Image size 2352x1568; retinal fundus photograph; 45° field of view.
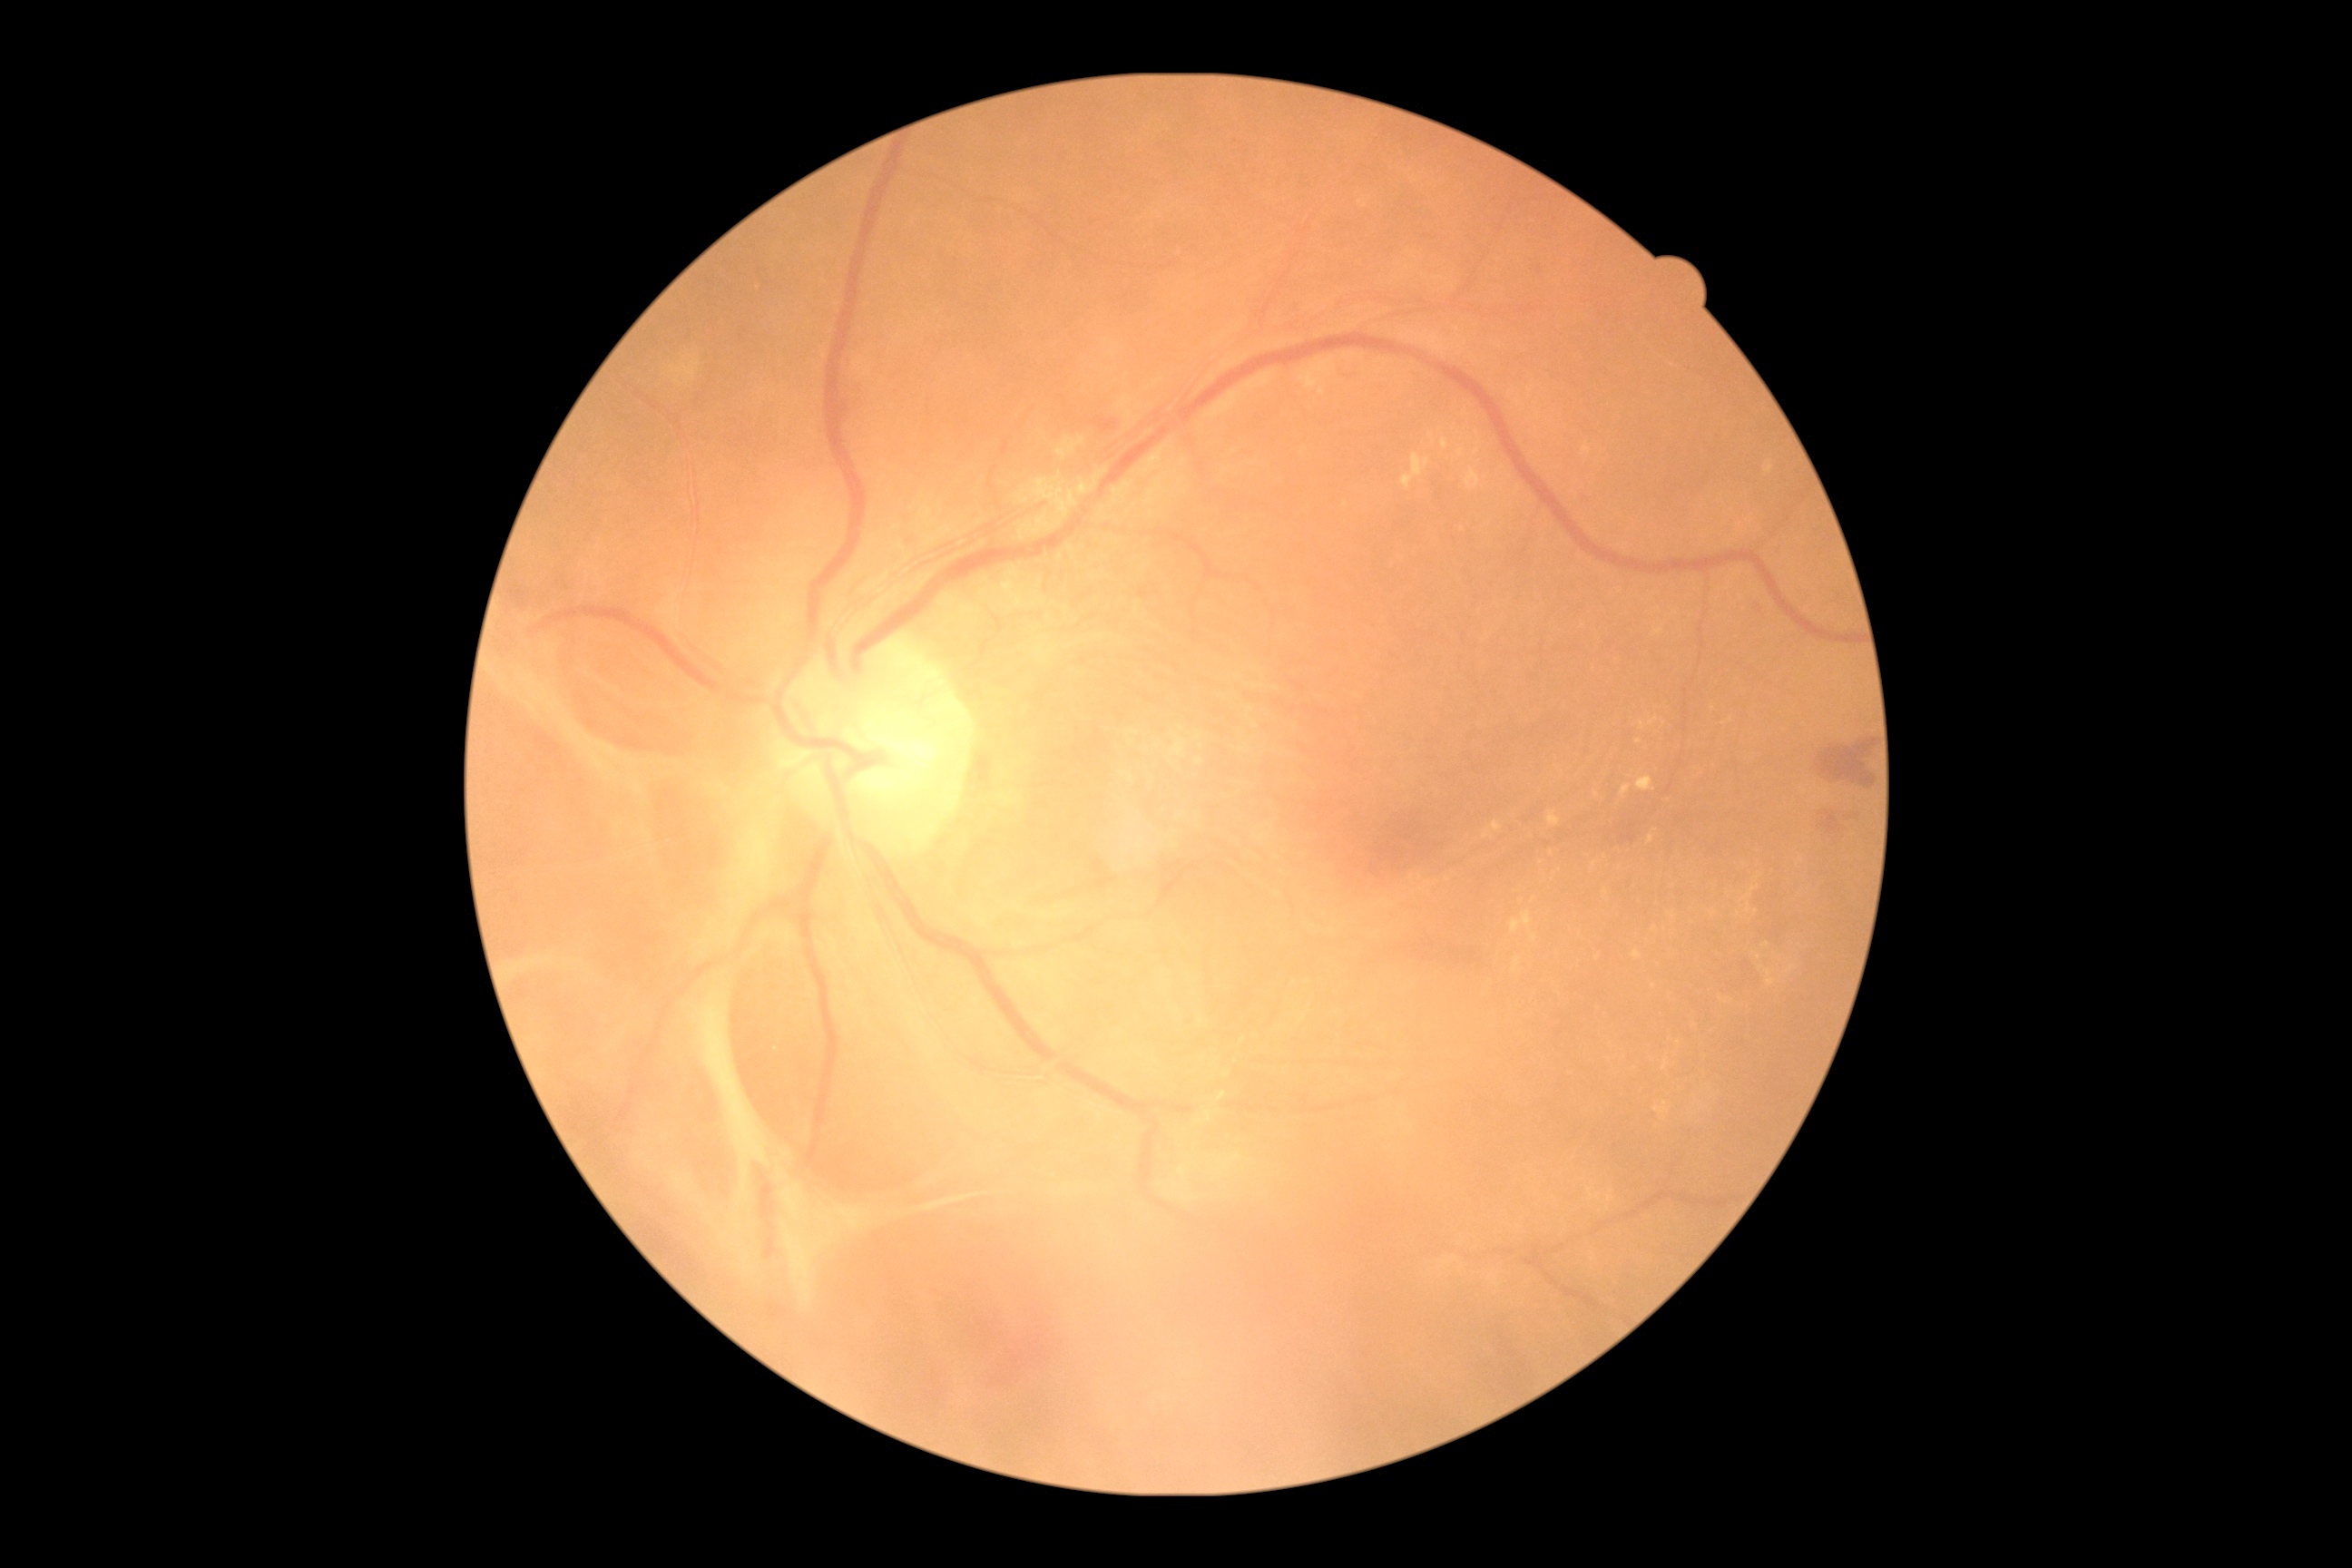
Retinopathy: proliferative diabetic retinopathy (grade 4).